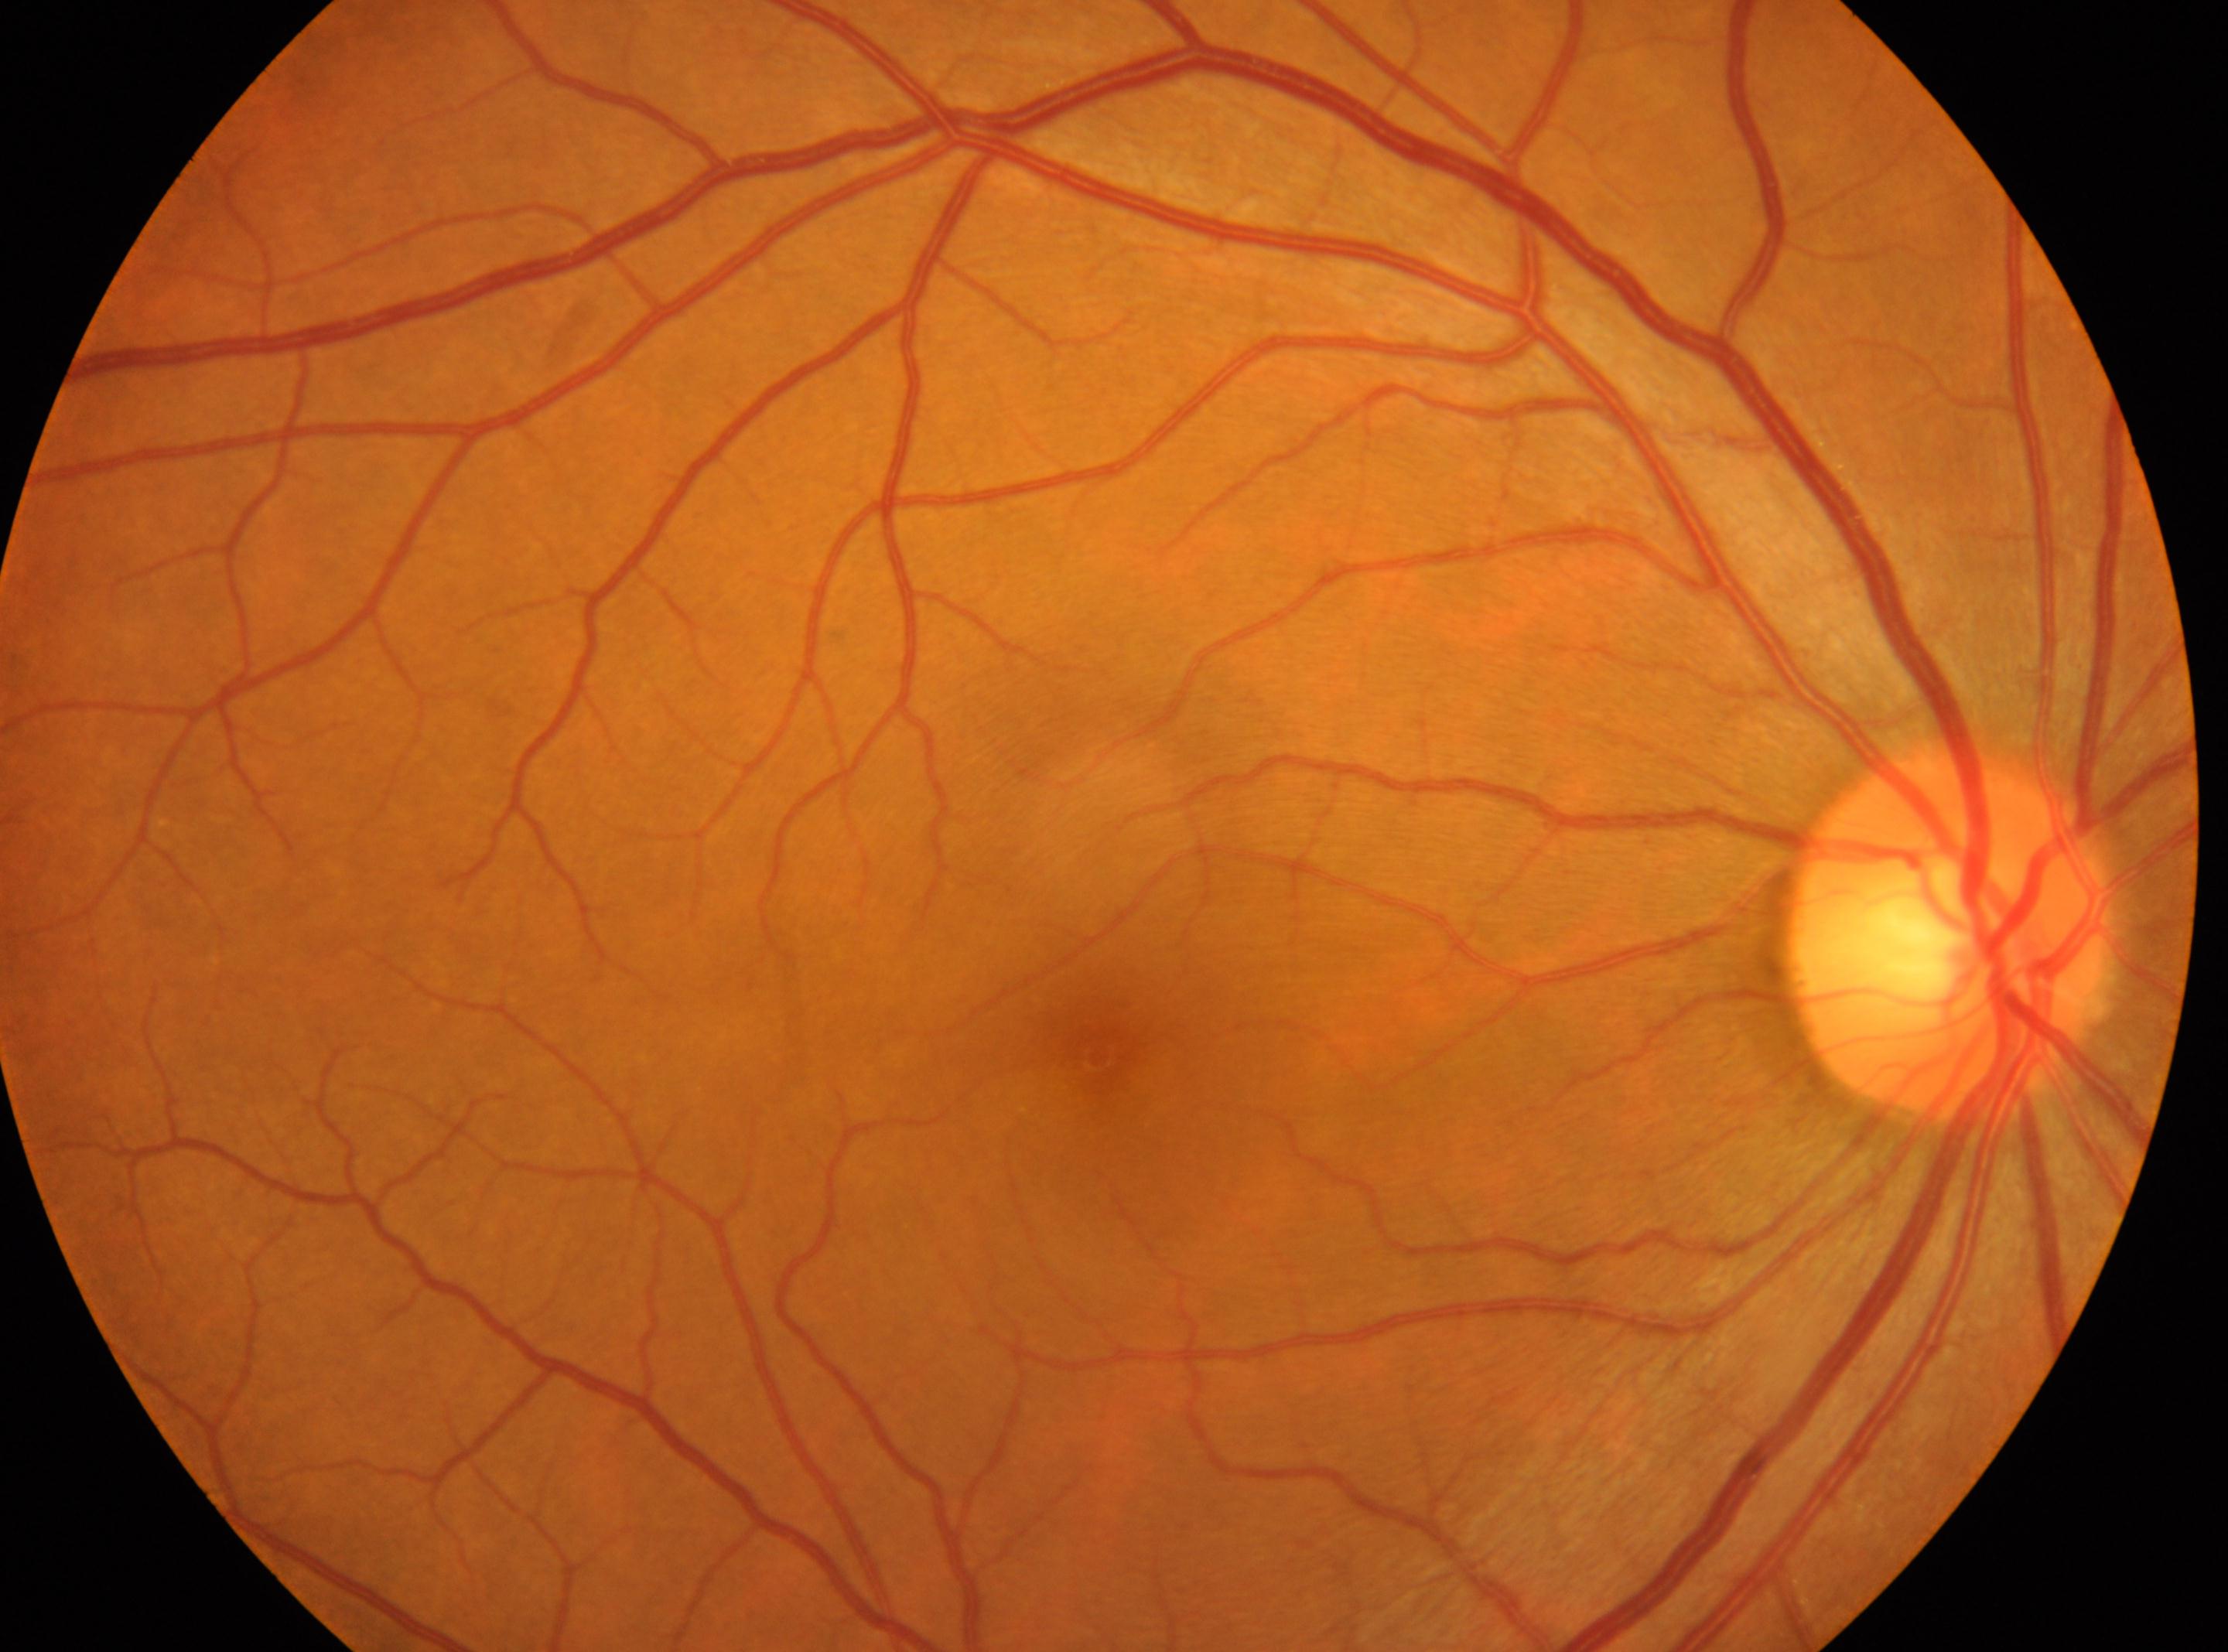

Fovea: 1099, 1055.
No DR findings.
Eye: oculus dexter.
DR is no apparent diabetic retinopathy (grade 0) — no visible signs of diabetic retinopathy.
The optic disc is at 1947, 934.